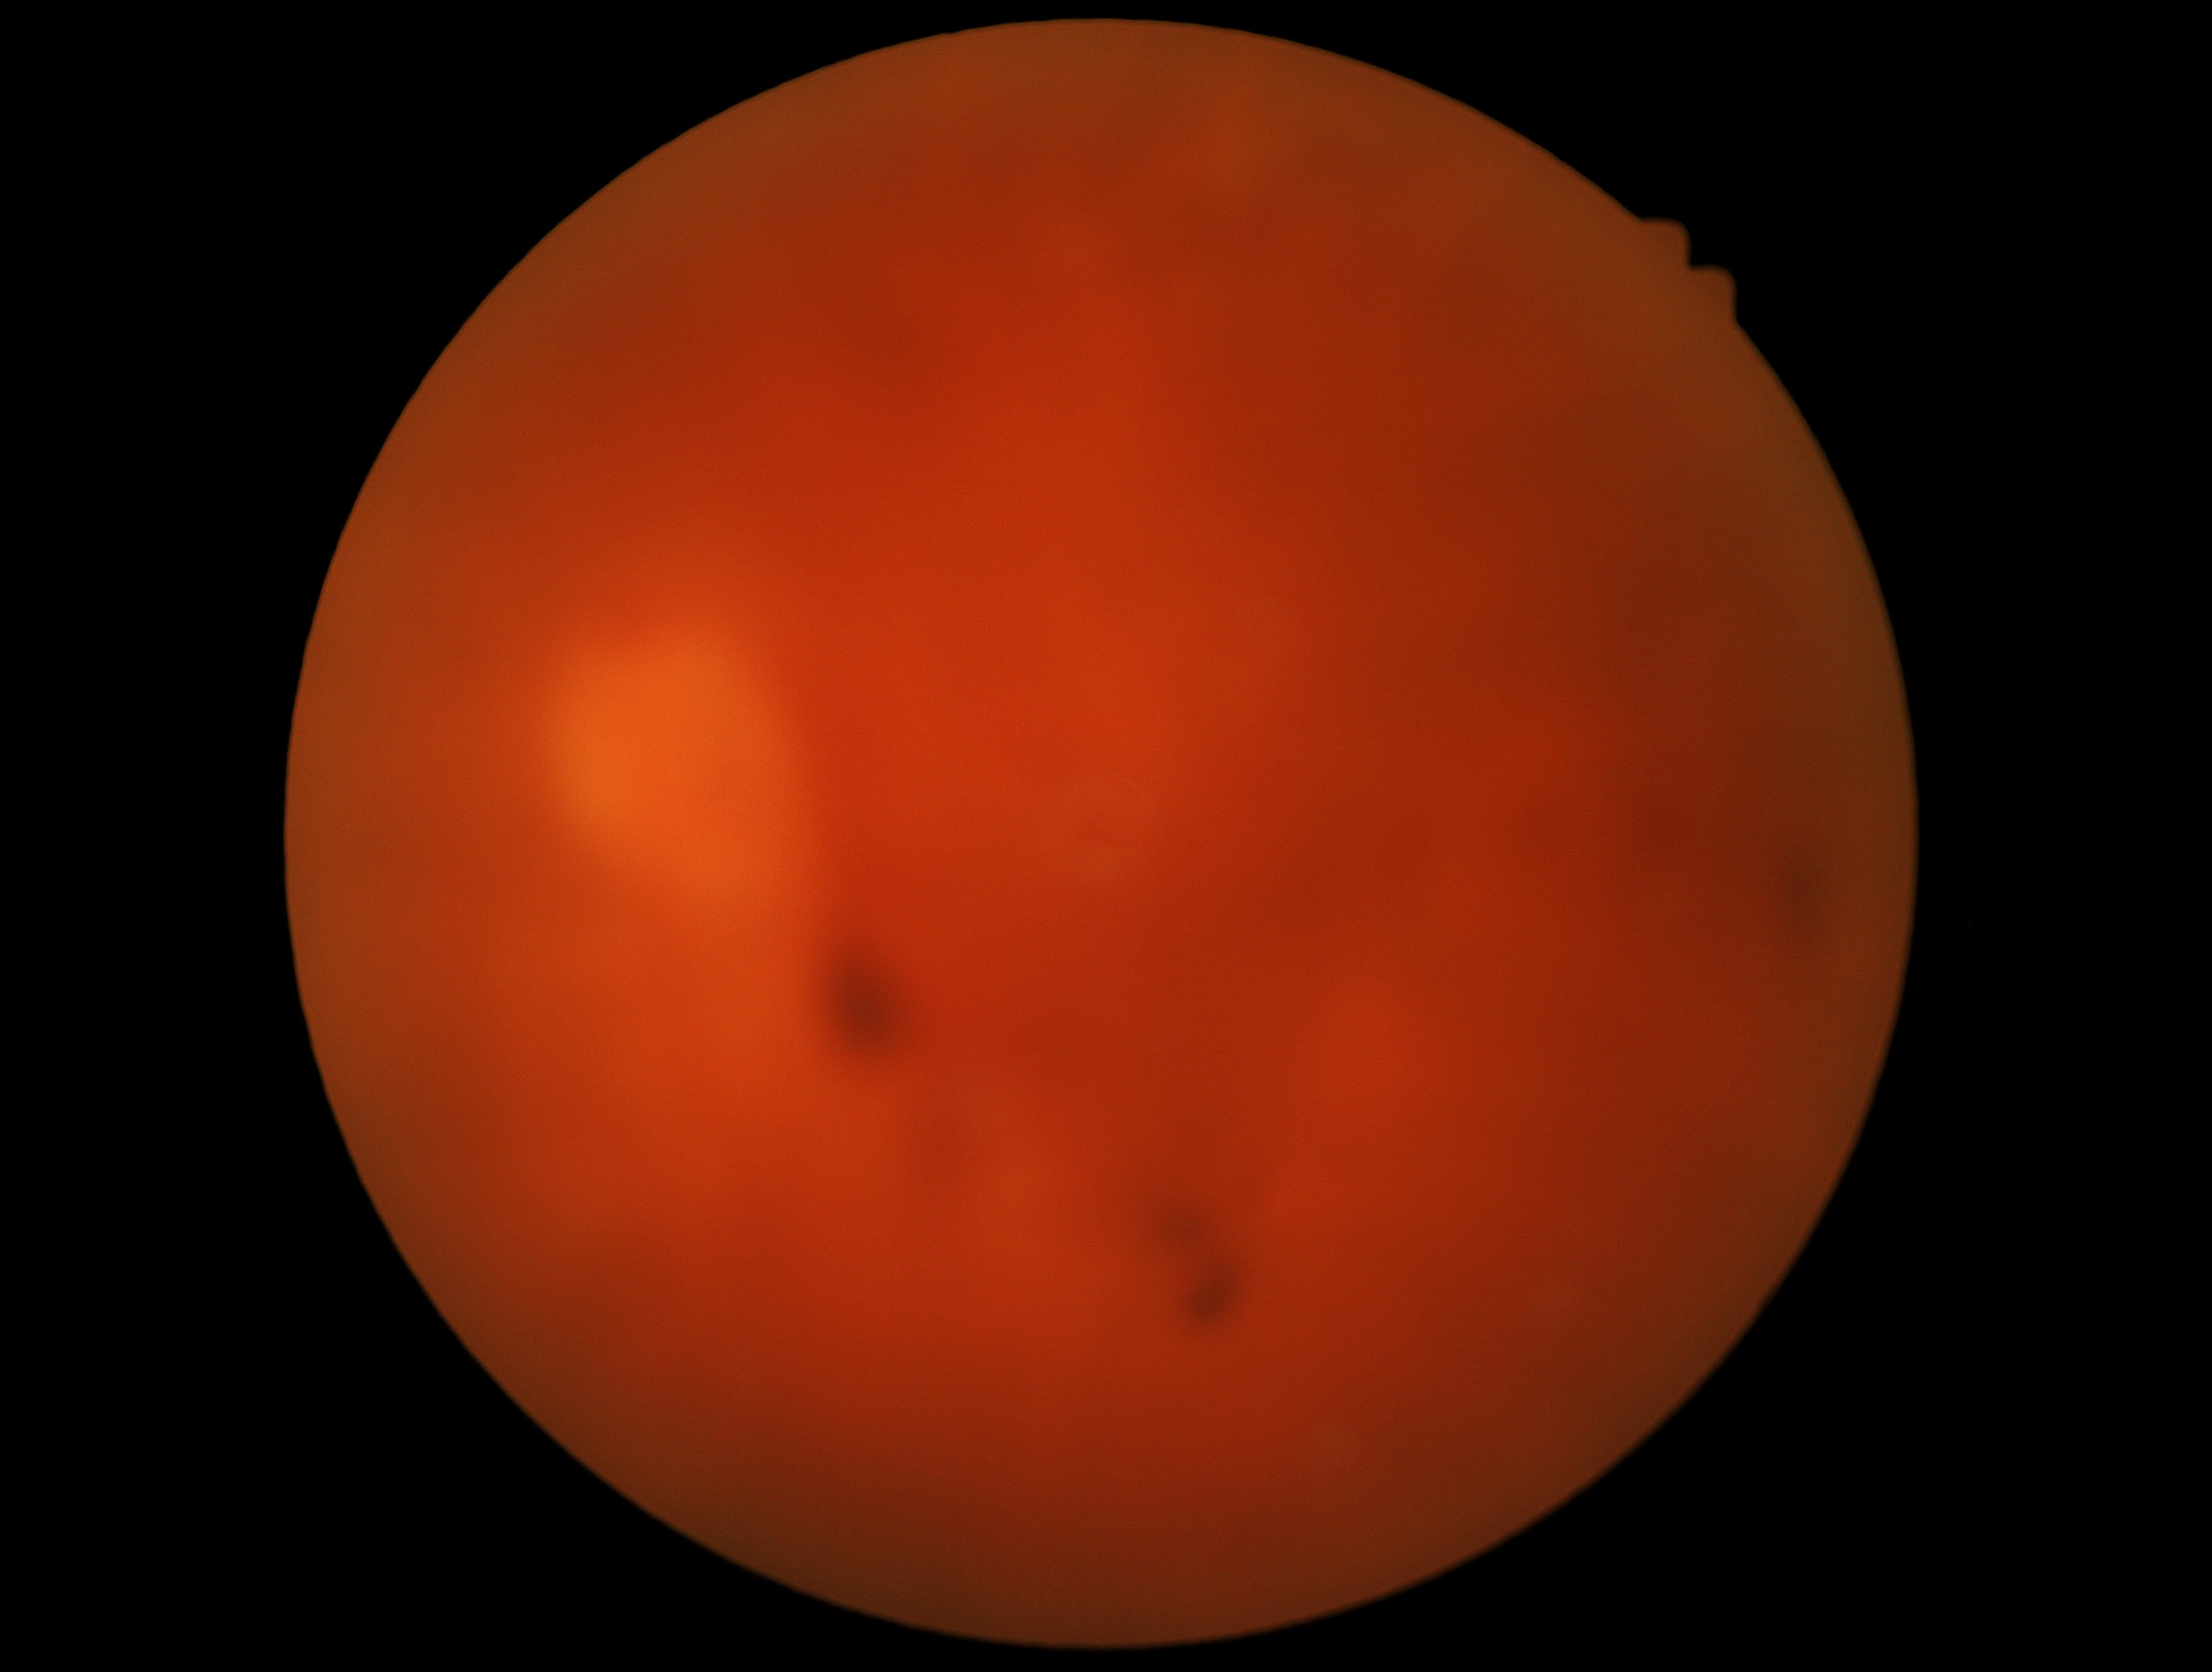
diabetic retinopathy grade@ungradable due to poor image quality; image quality@insufficient.